640 x 480 pixels. Pediatric wide-field fundus photograph. Clarity RetCam 3, 130° FOV.
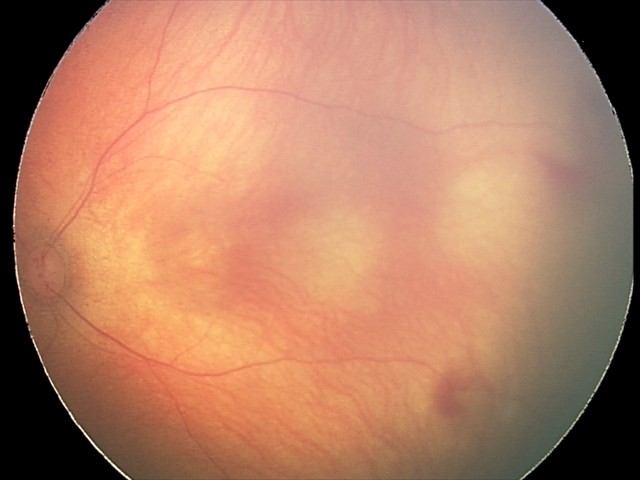 Assessment: retinal hemorrhages.